NIDEK AFC-230 — 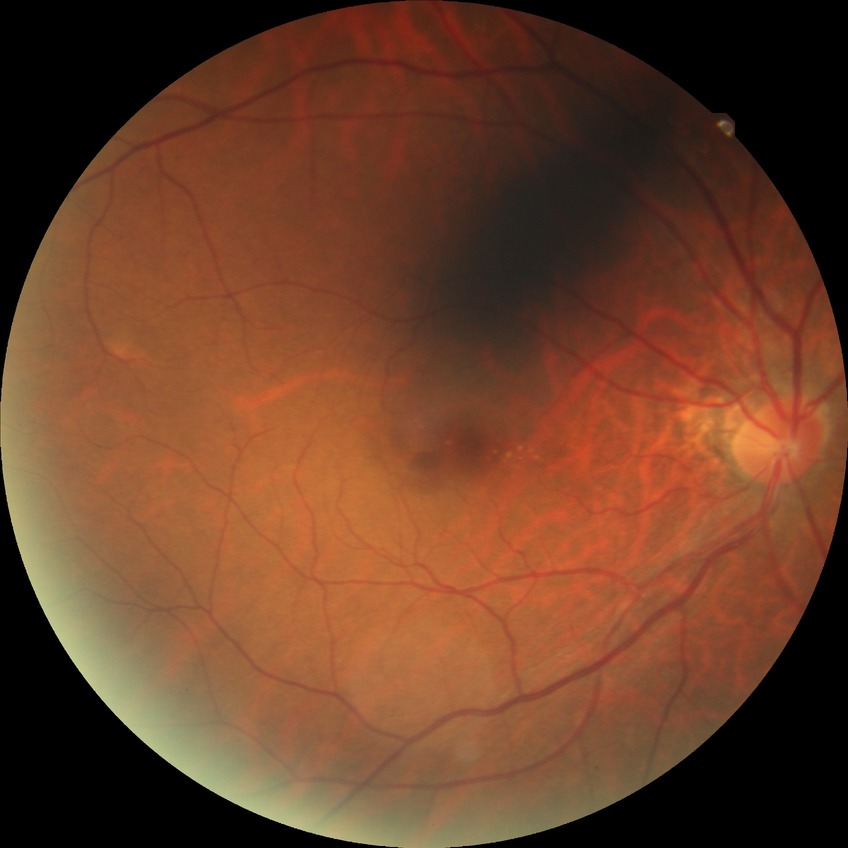

DR impression: no DR findings | DR: NDR.